45° FOV. Fundus photo
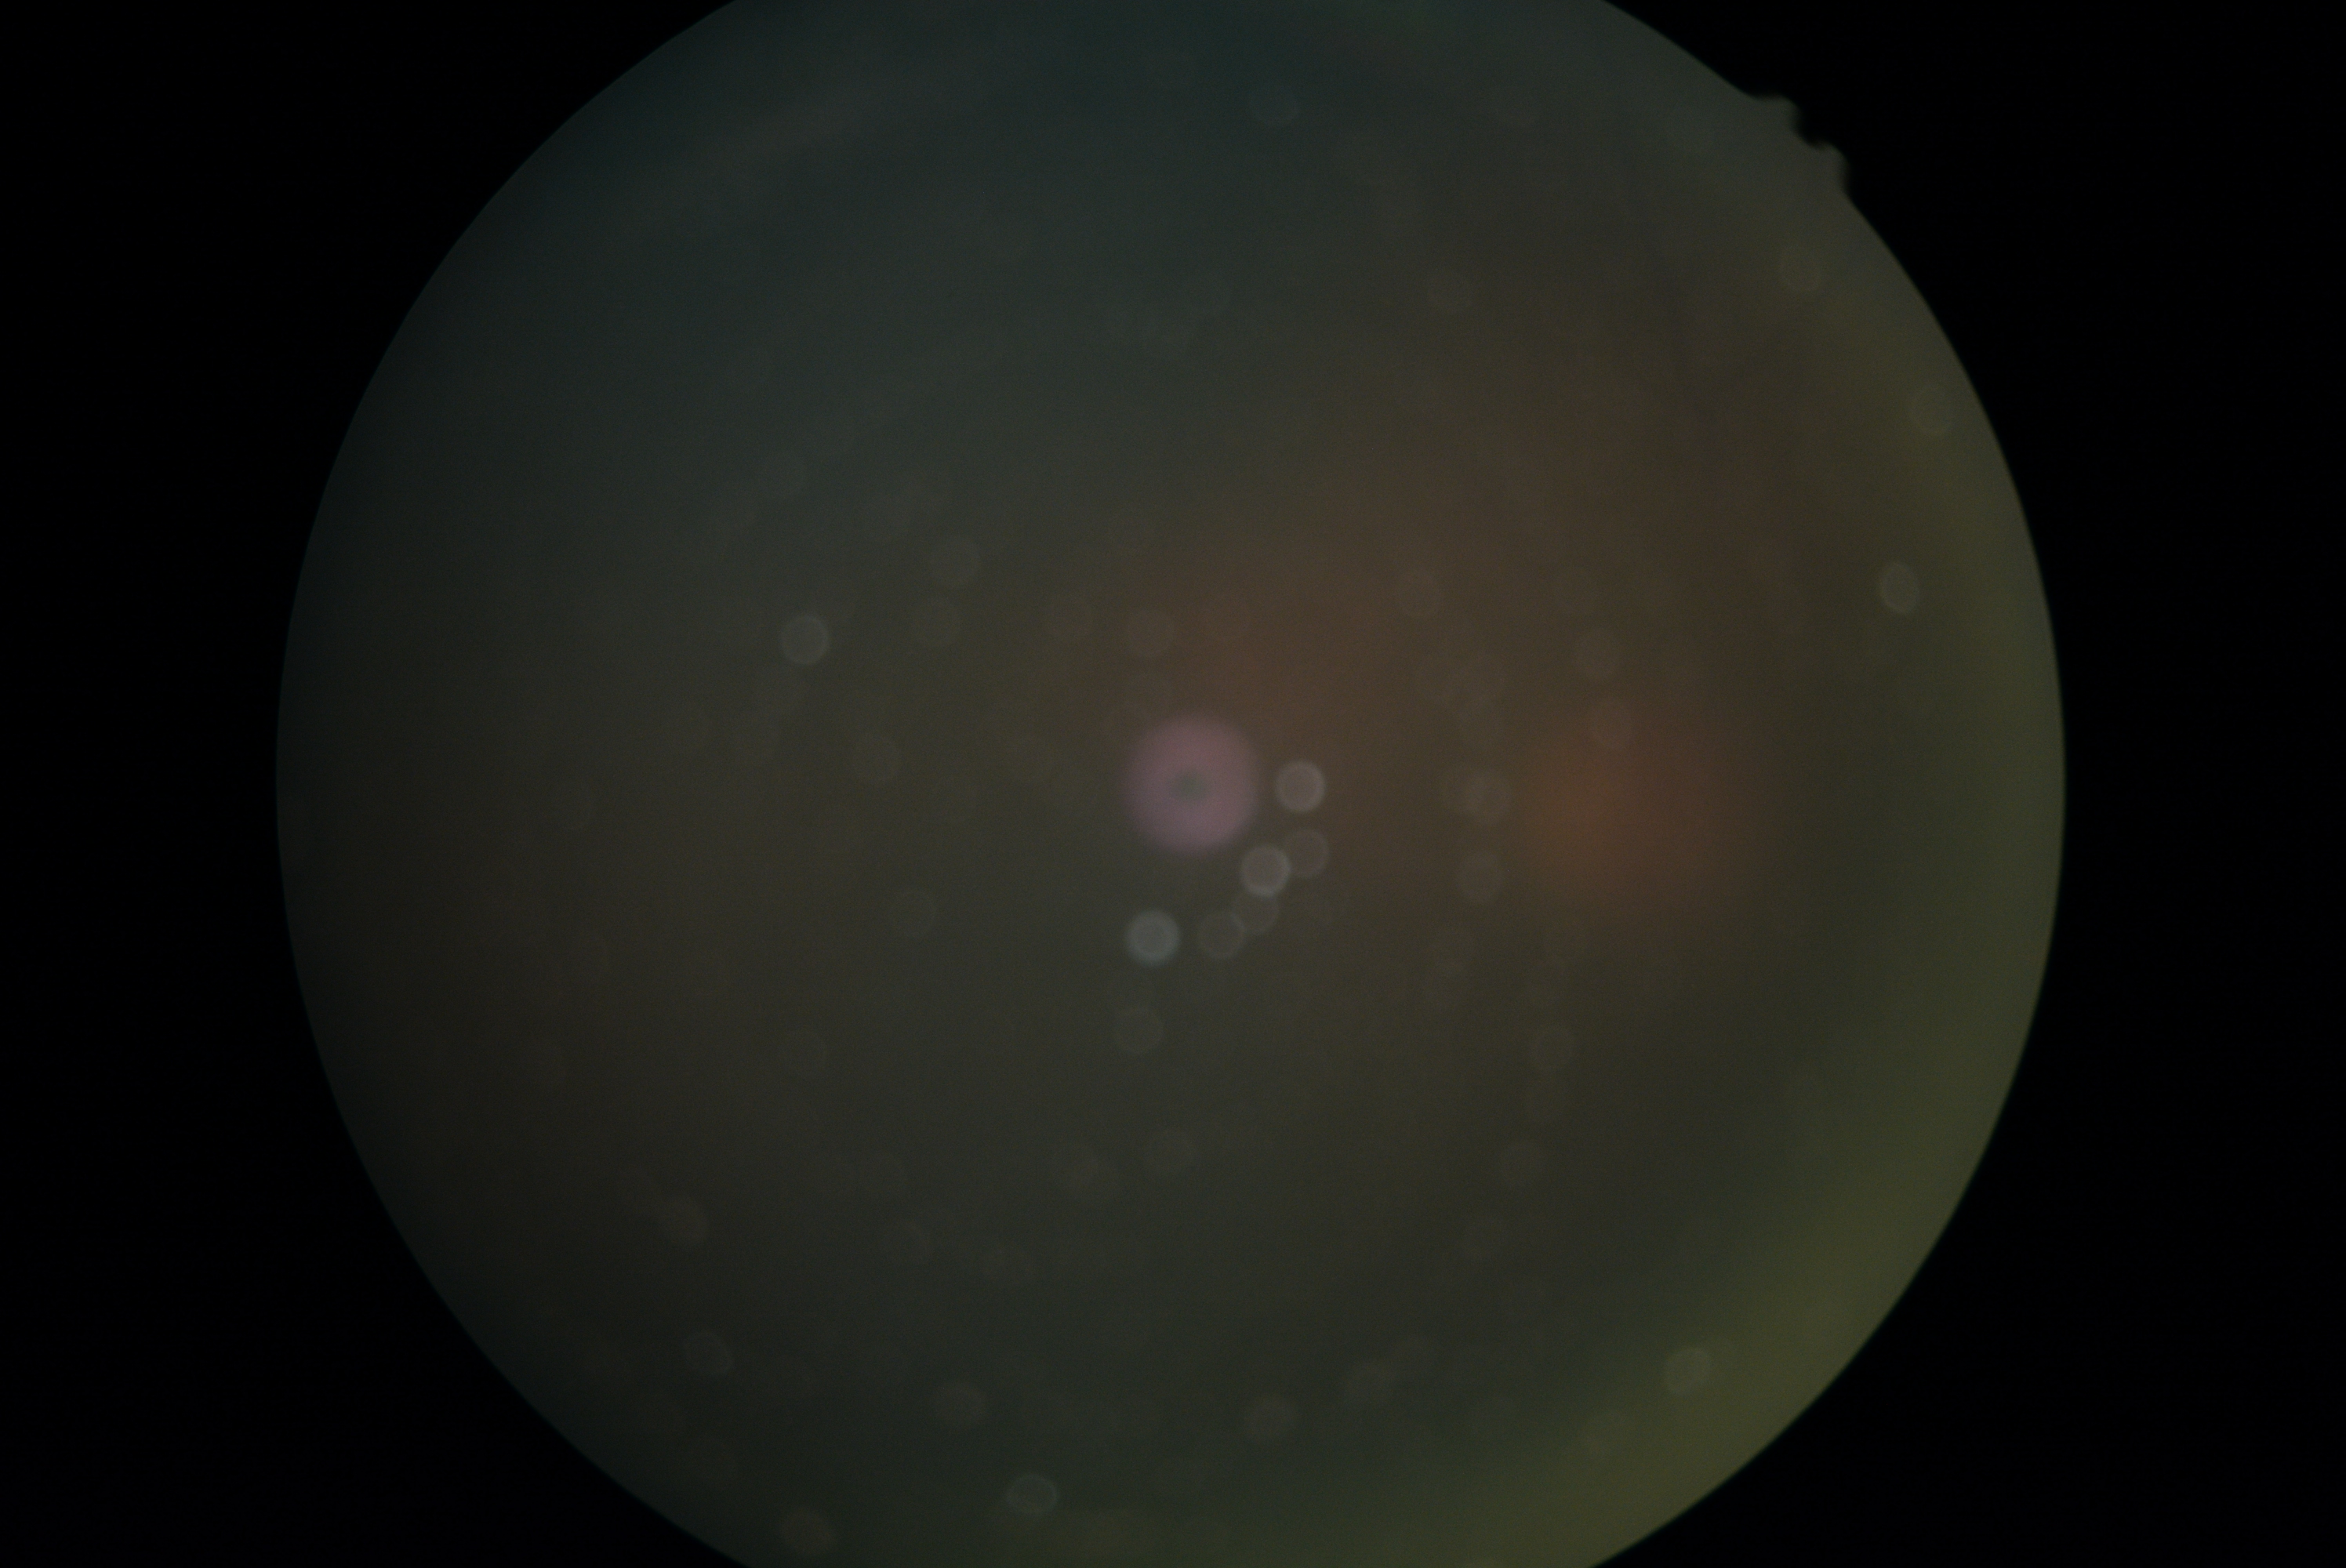
Image quality is insufficient for diabetic retinopathy assessment.
DR grade: ungradable.